Diabetic retinopathy graded by the modified Davis classification.
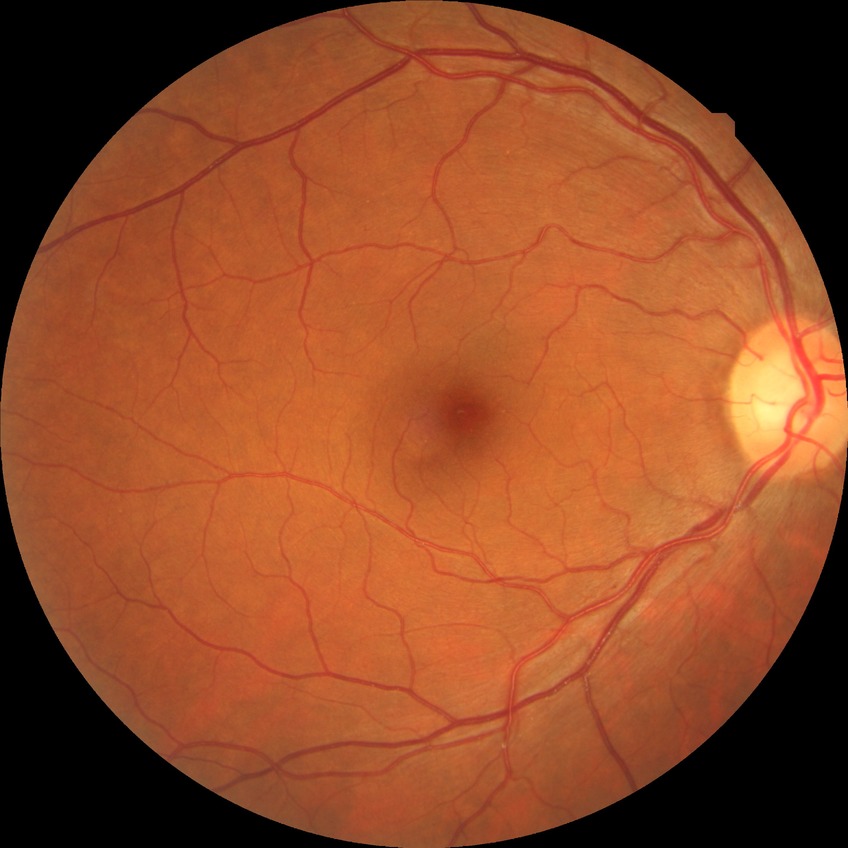
Retinopathy stage is no diabetic retinopathy.